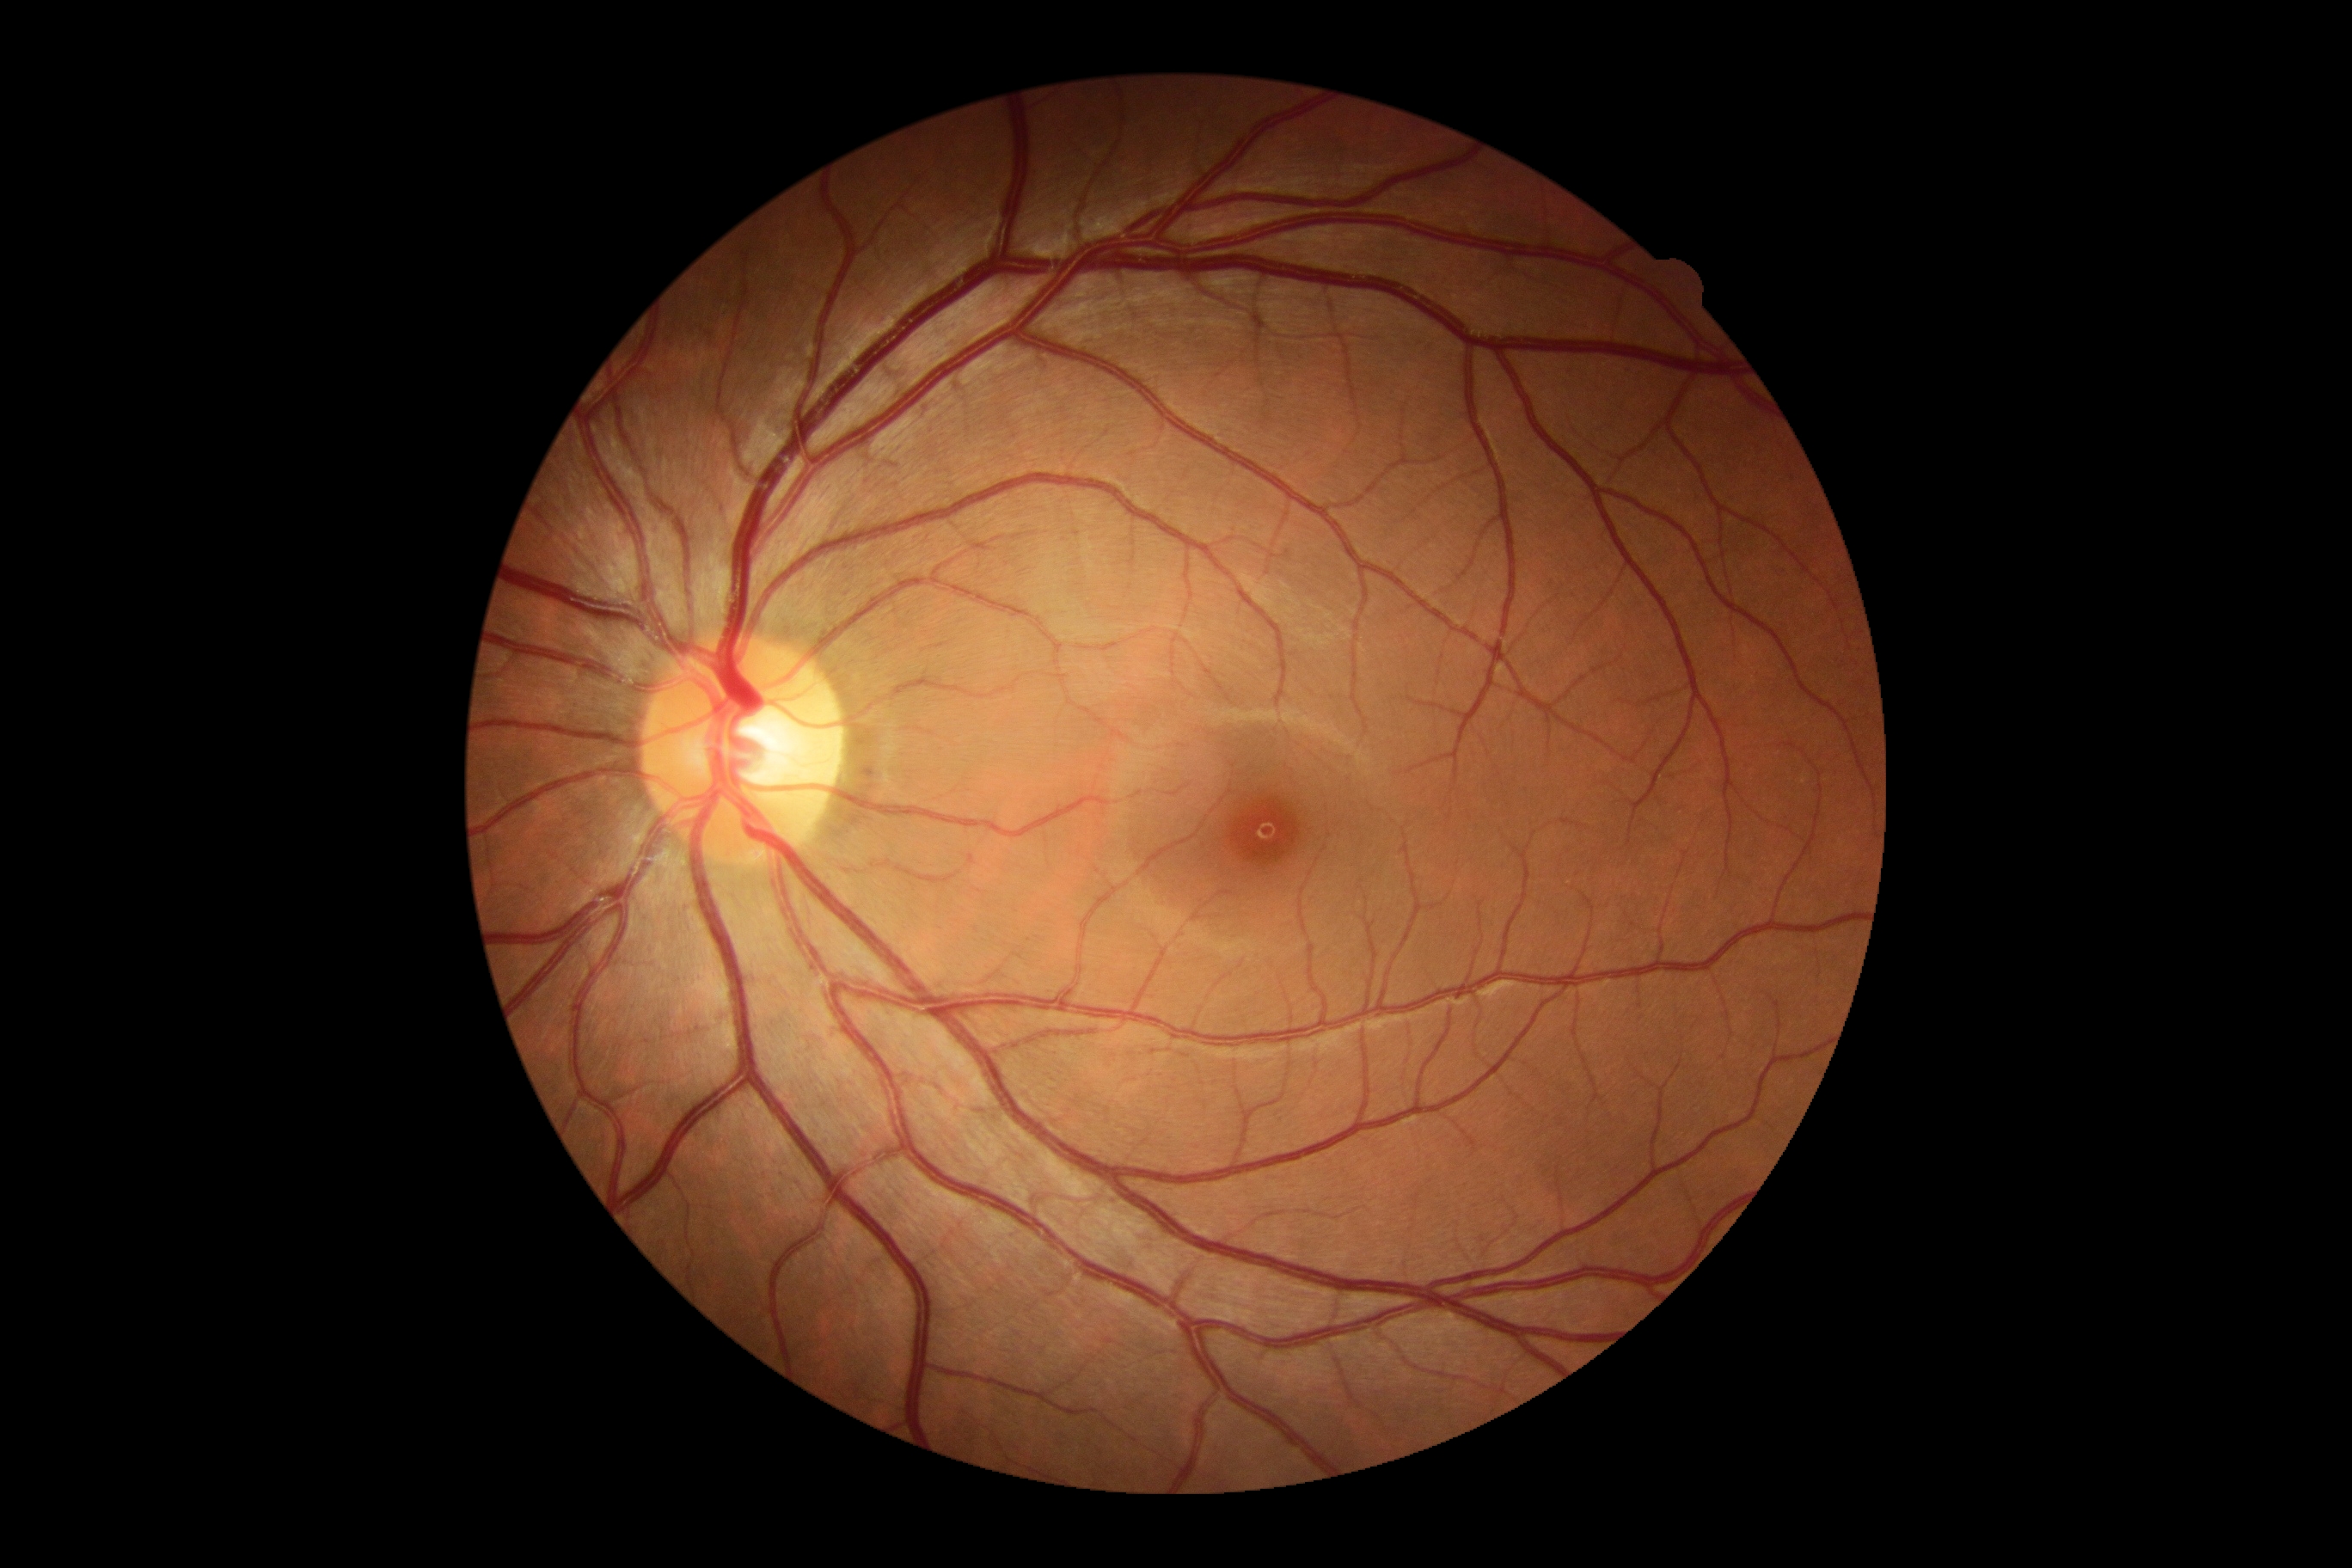

diabetic retinopathy severity = 0.